Retinal fundus photograph, NIDEK AFC-230, no pharmacologic dilation, 45 degree fundus photograph:
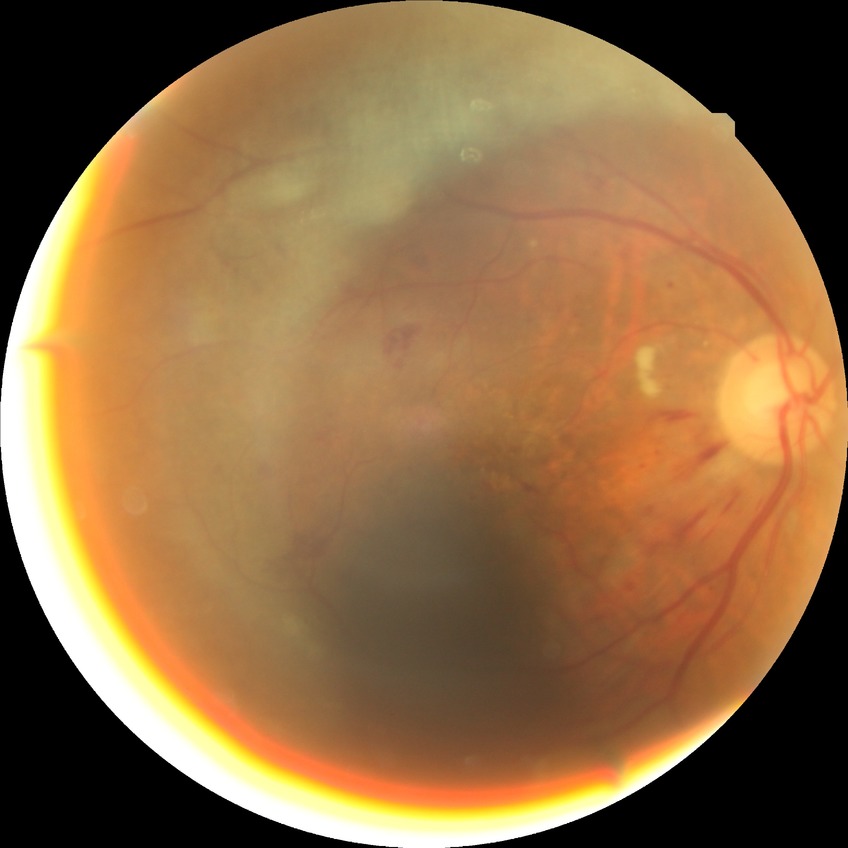
Diabetic retinopathy severity is pre-proliferative diabetic retinopathy.